1240x1240 · pediatric wide-field fundus photograph · captured with the Phoenix ICON (100° field of view) — 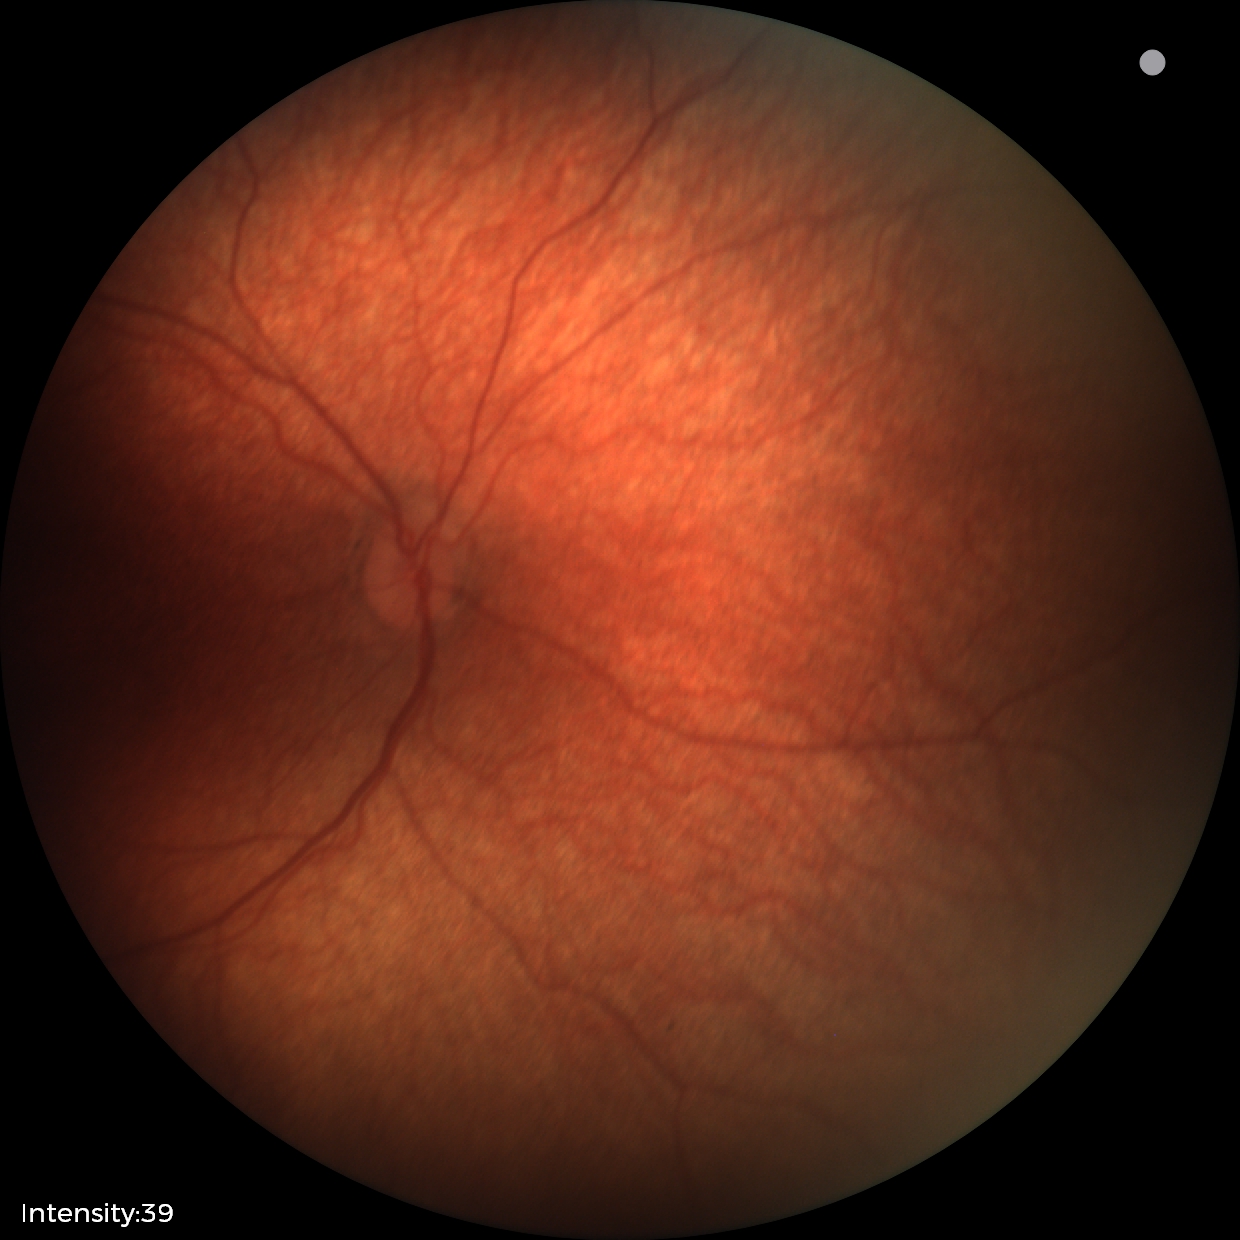 Screening examination diagnosed as physiological.